DR severity per modified Davis staging.
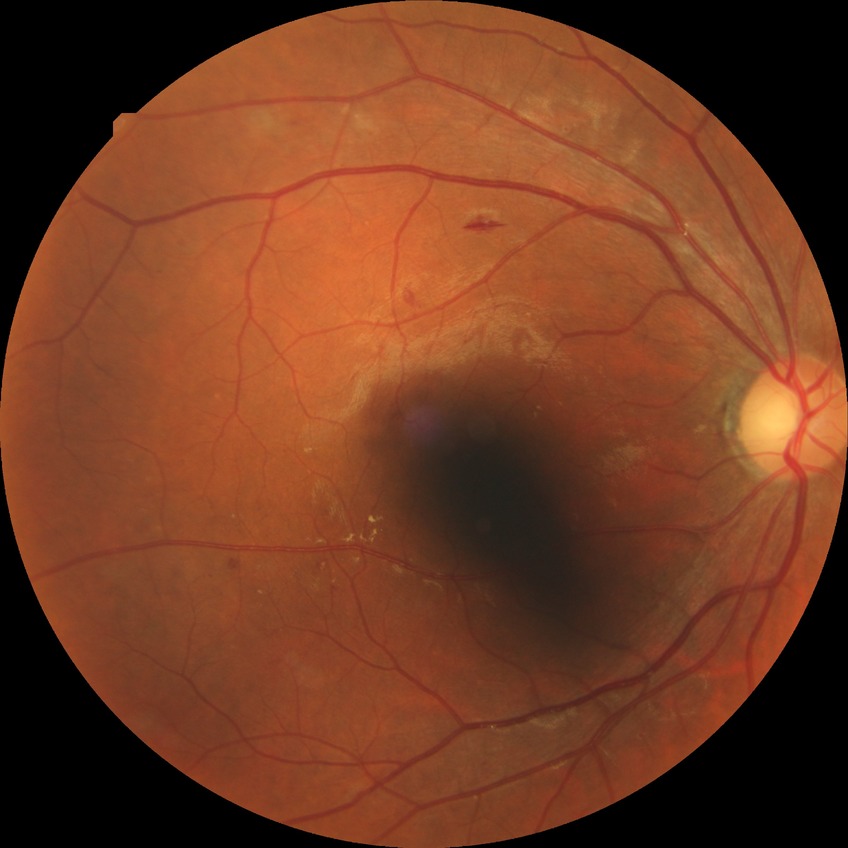
diabetic retinopathy grade: simple diabetic retinopathy; DR class: non-proliferative diabetic retinopathy.